Color fundus image
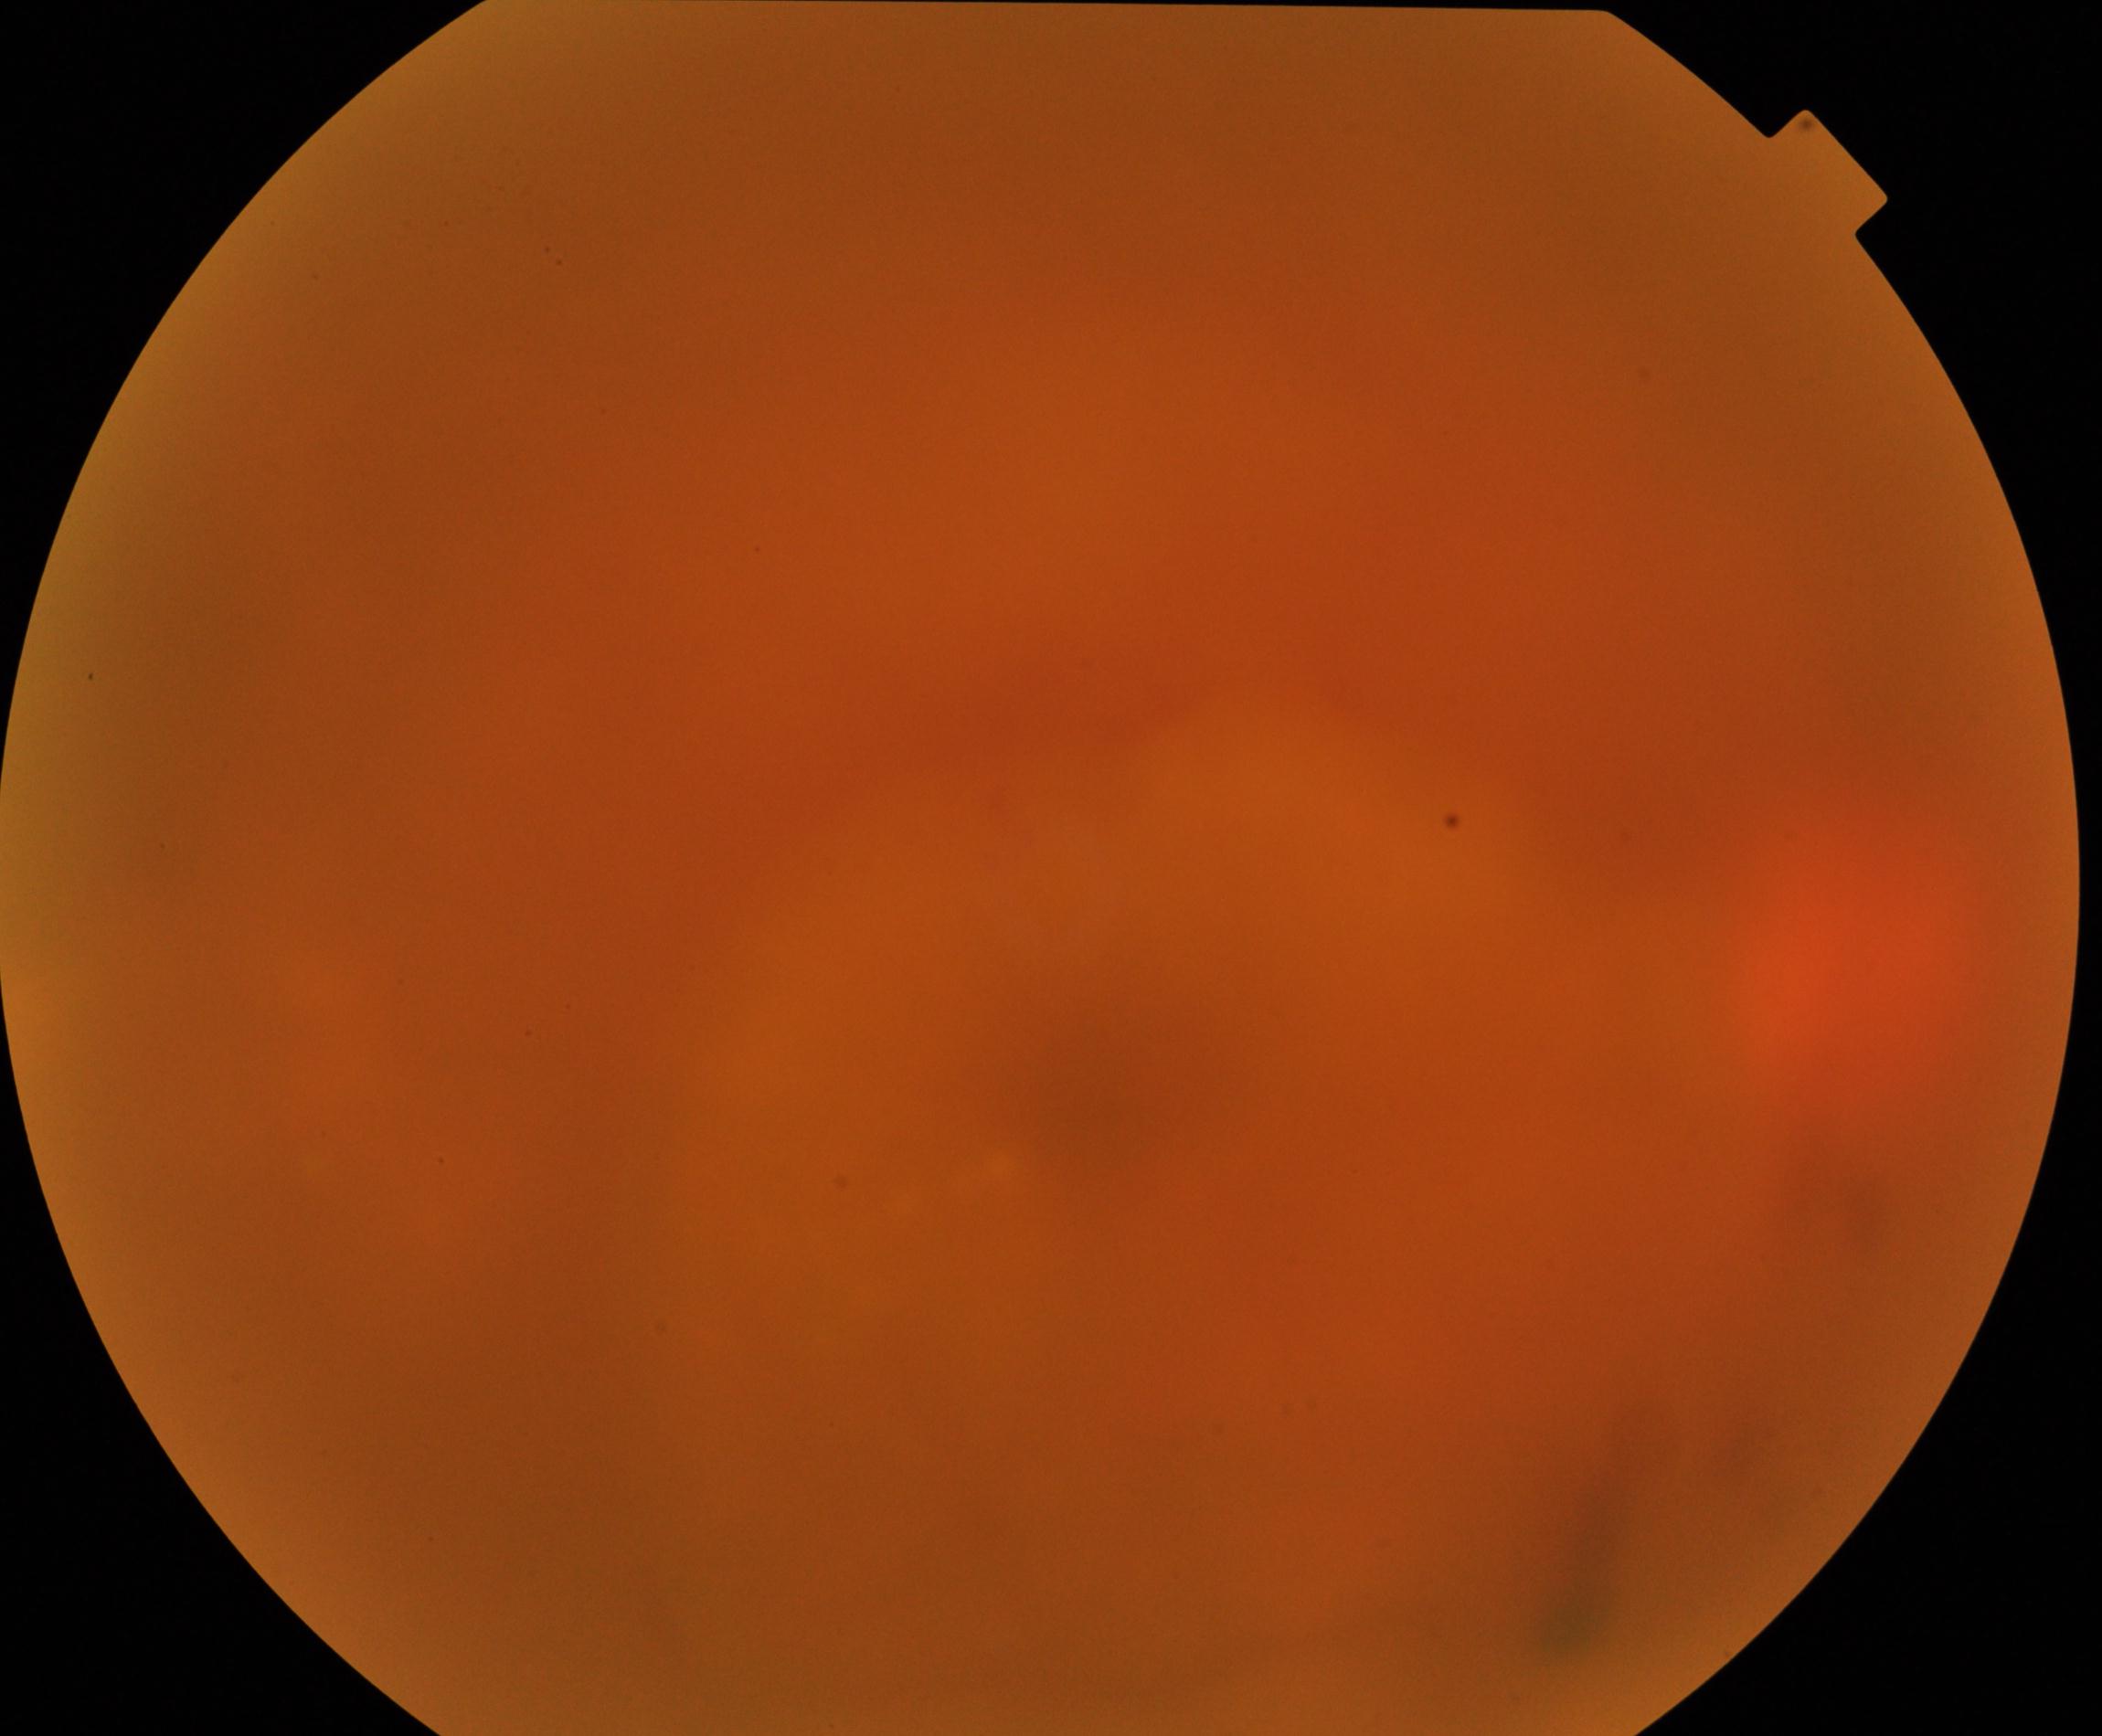
Gradability: significantly degraded. Proliferative retinopathy: no evidence.